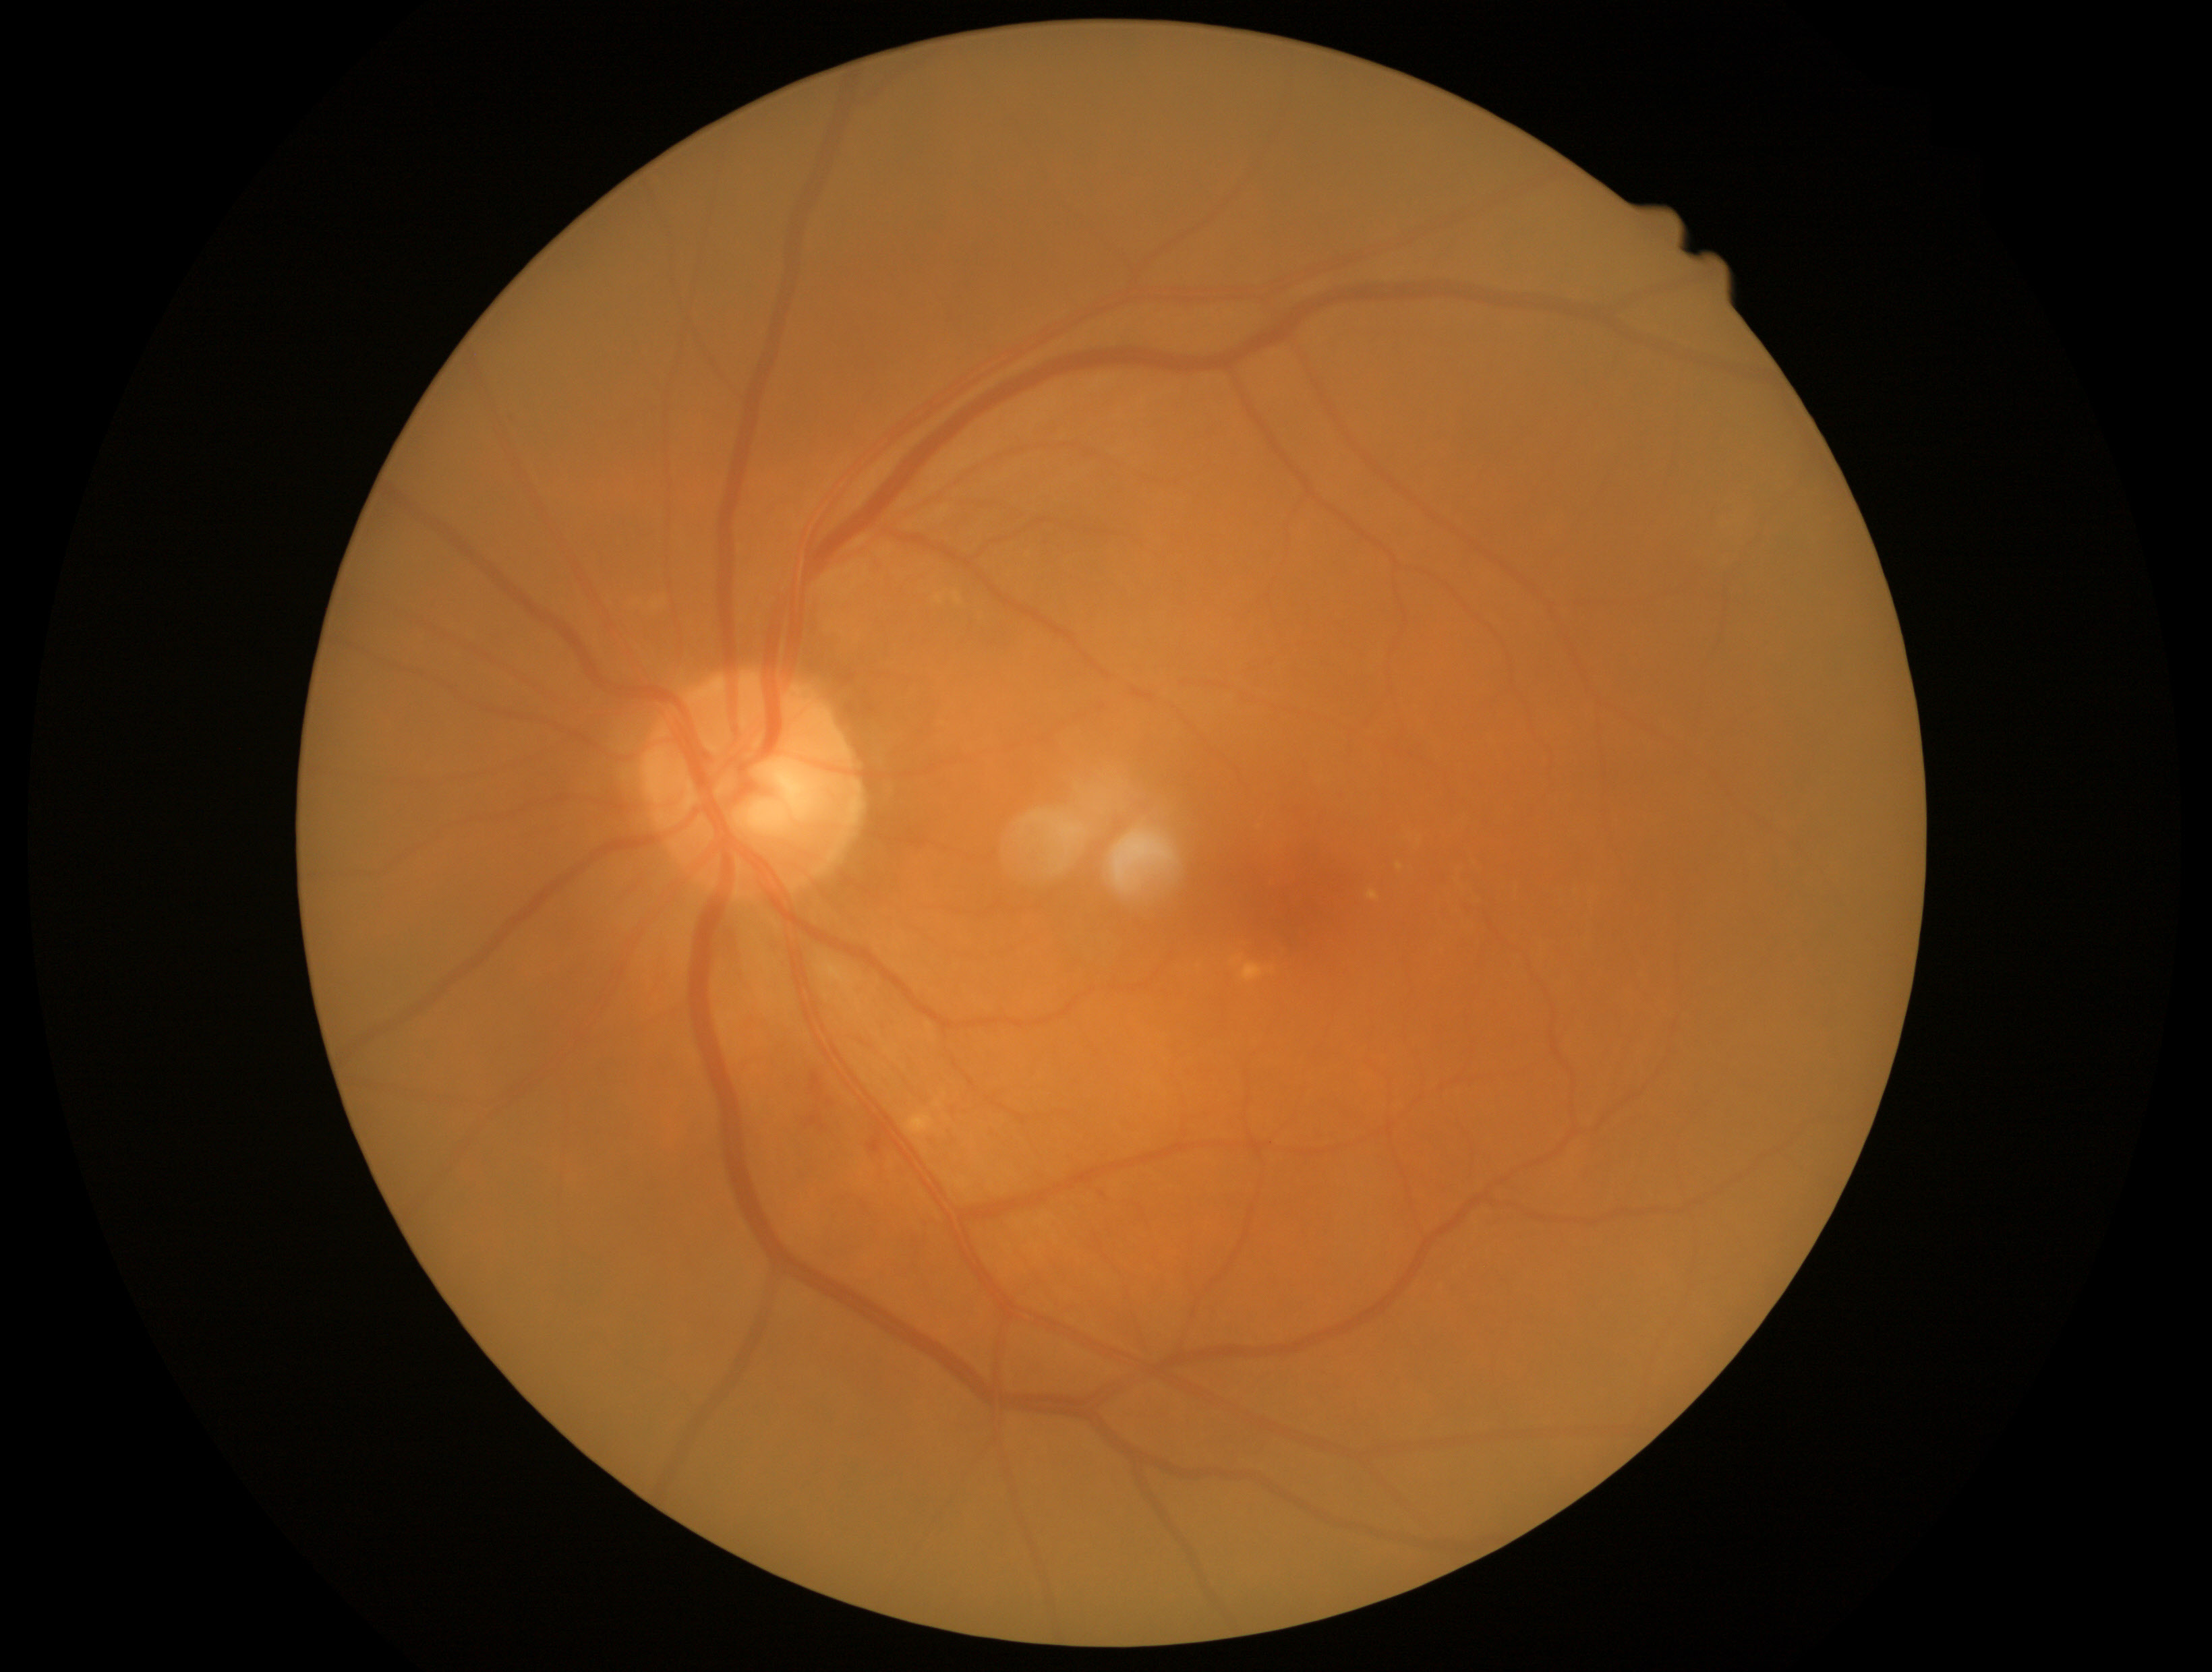

diabetic retinopathy severity=moderate non-proliferative diabetic retinopathy (grade 2).